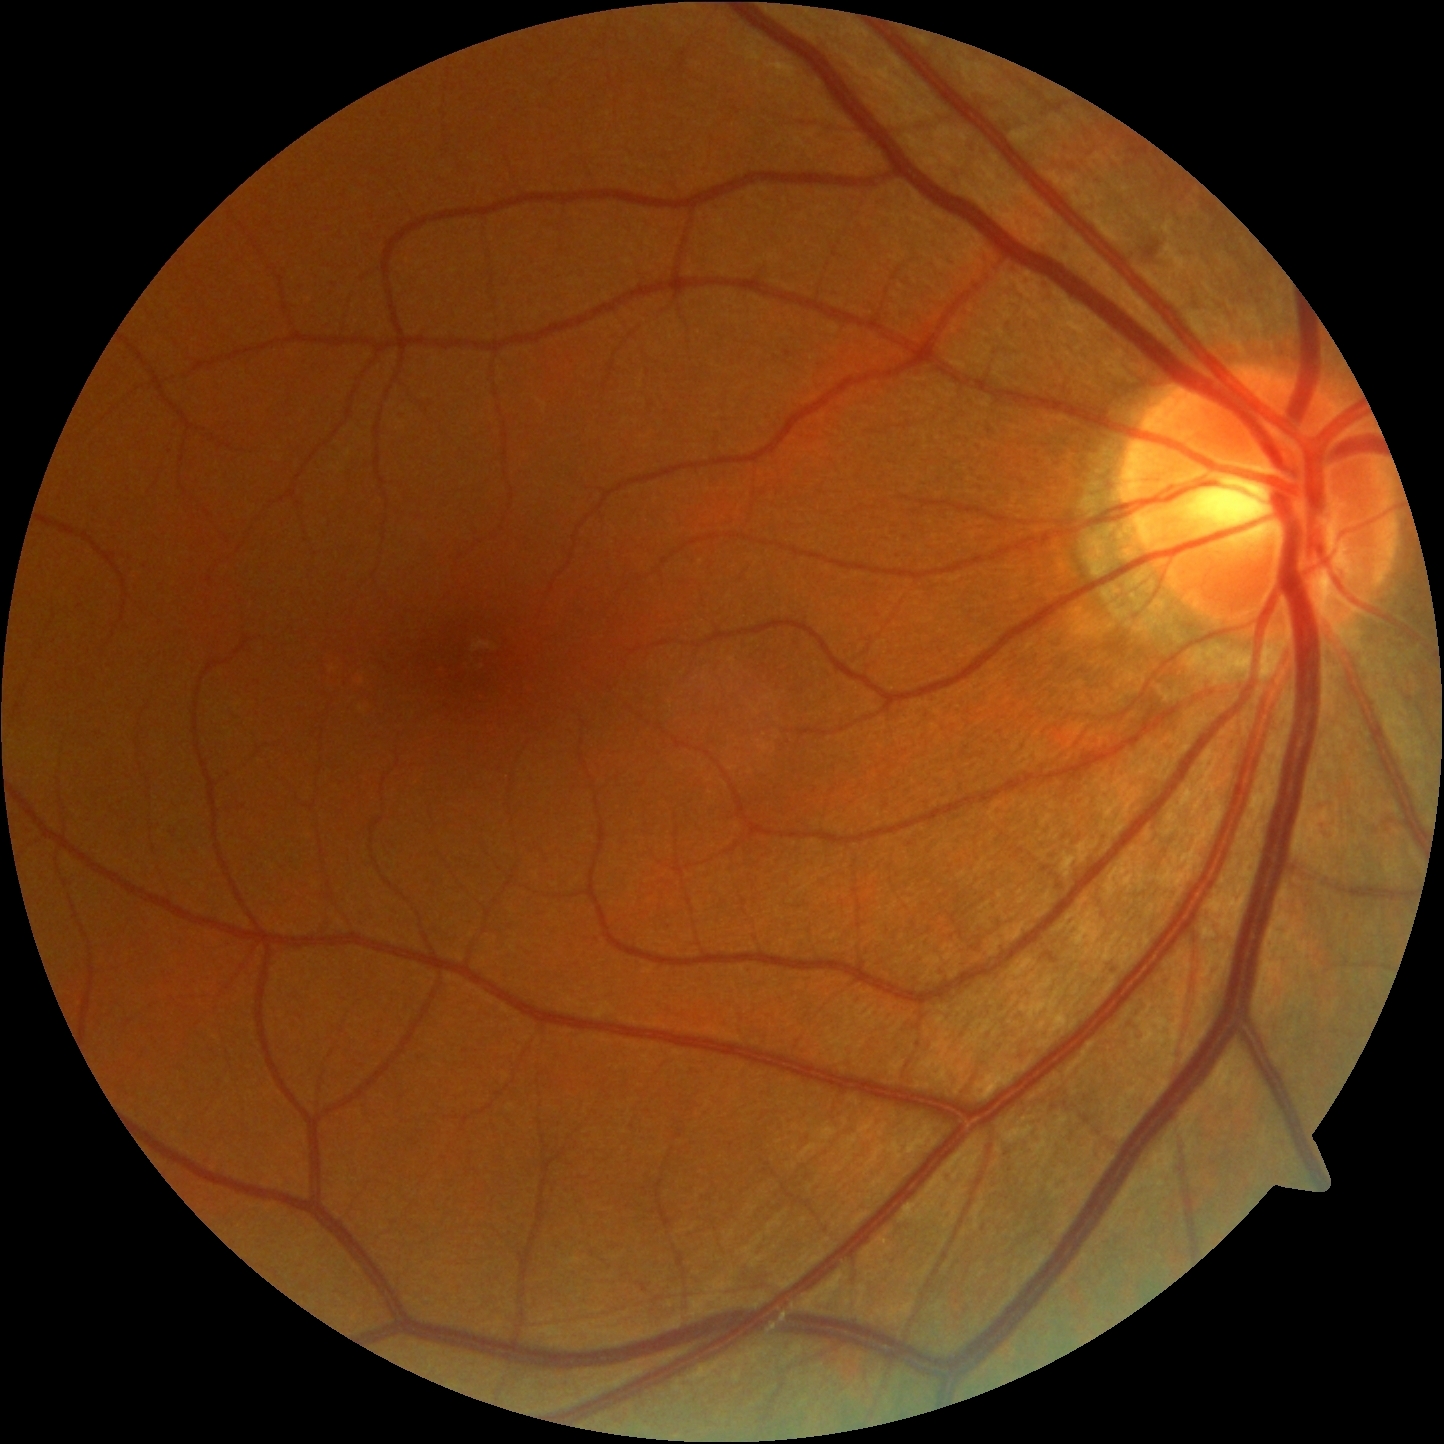 diabetic retinopathy (DR): 2/4.